Wide-field contact fundus photograph of an infant; image size 1240x1240:
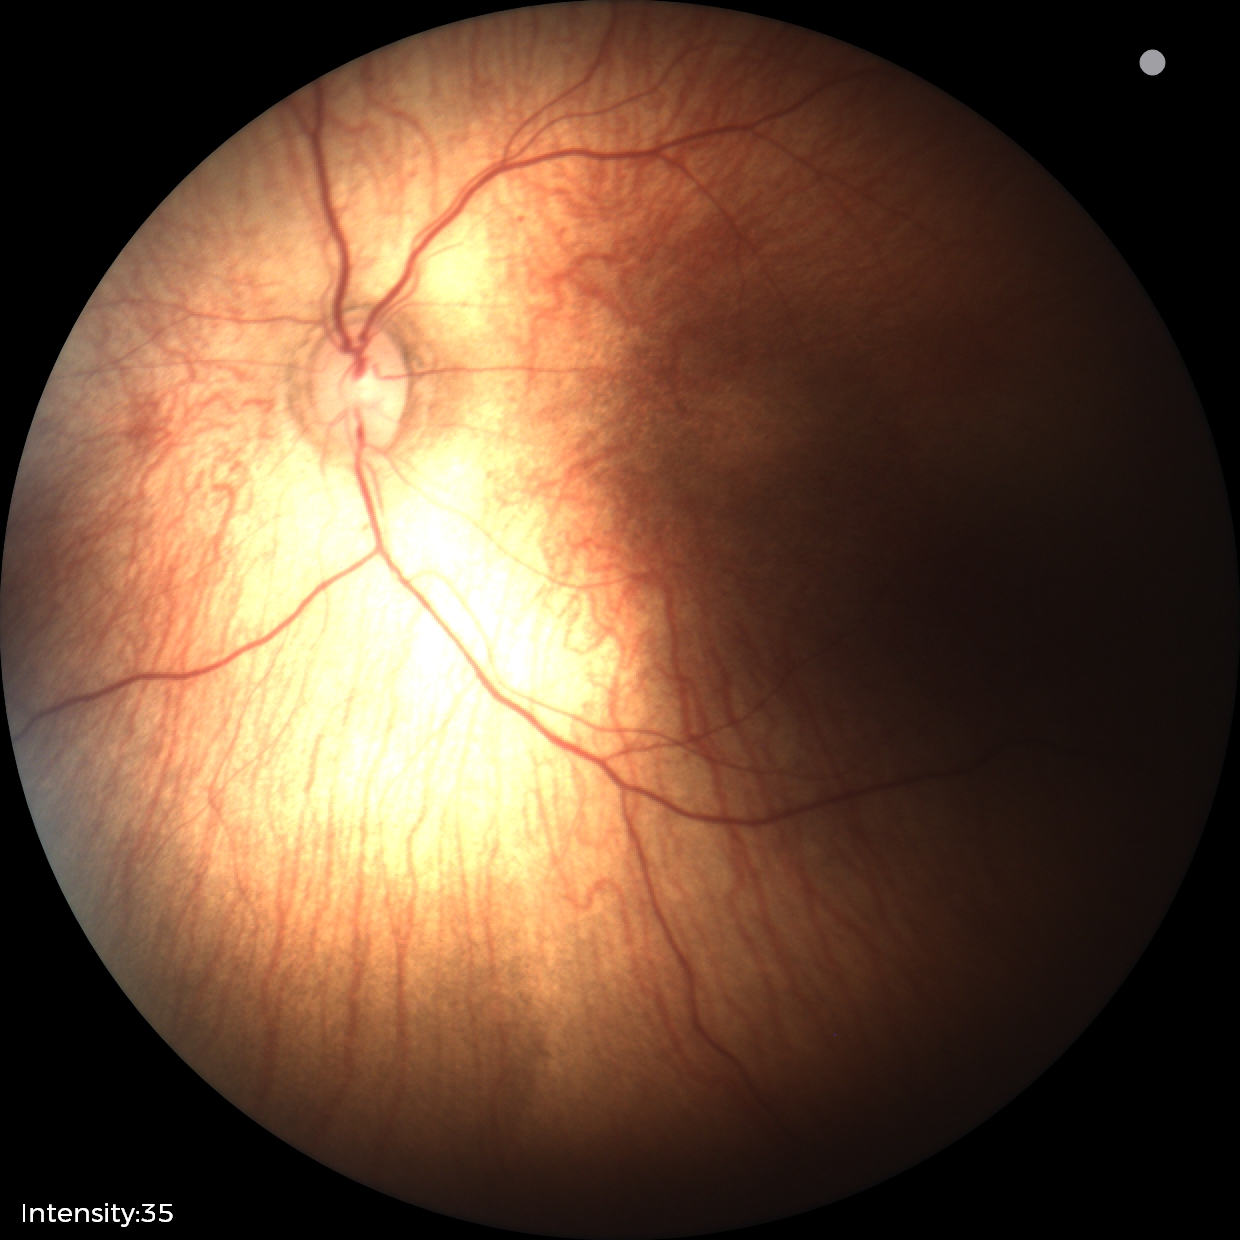

Examination diagnosed as status post retinopathy of prematurity.